Nonmydriatic fundus photograph · posterior pole photograph · 45-degree field of view — 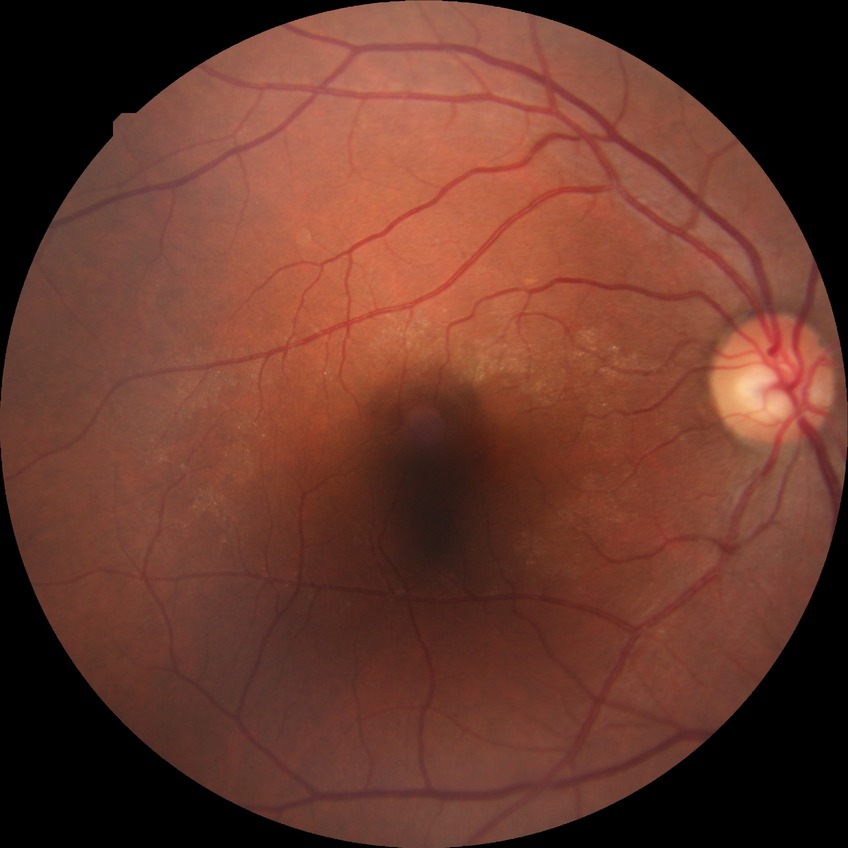
DR grade is NDR.